Color fundus photograph · Remidio Fundus on Phone — 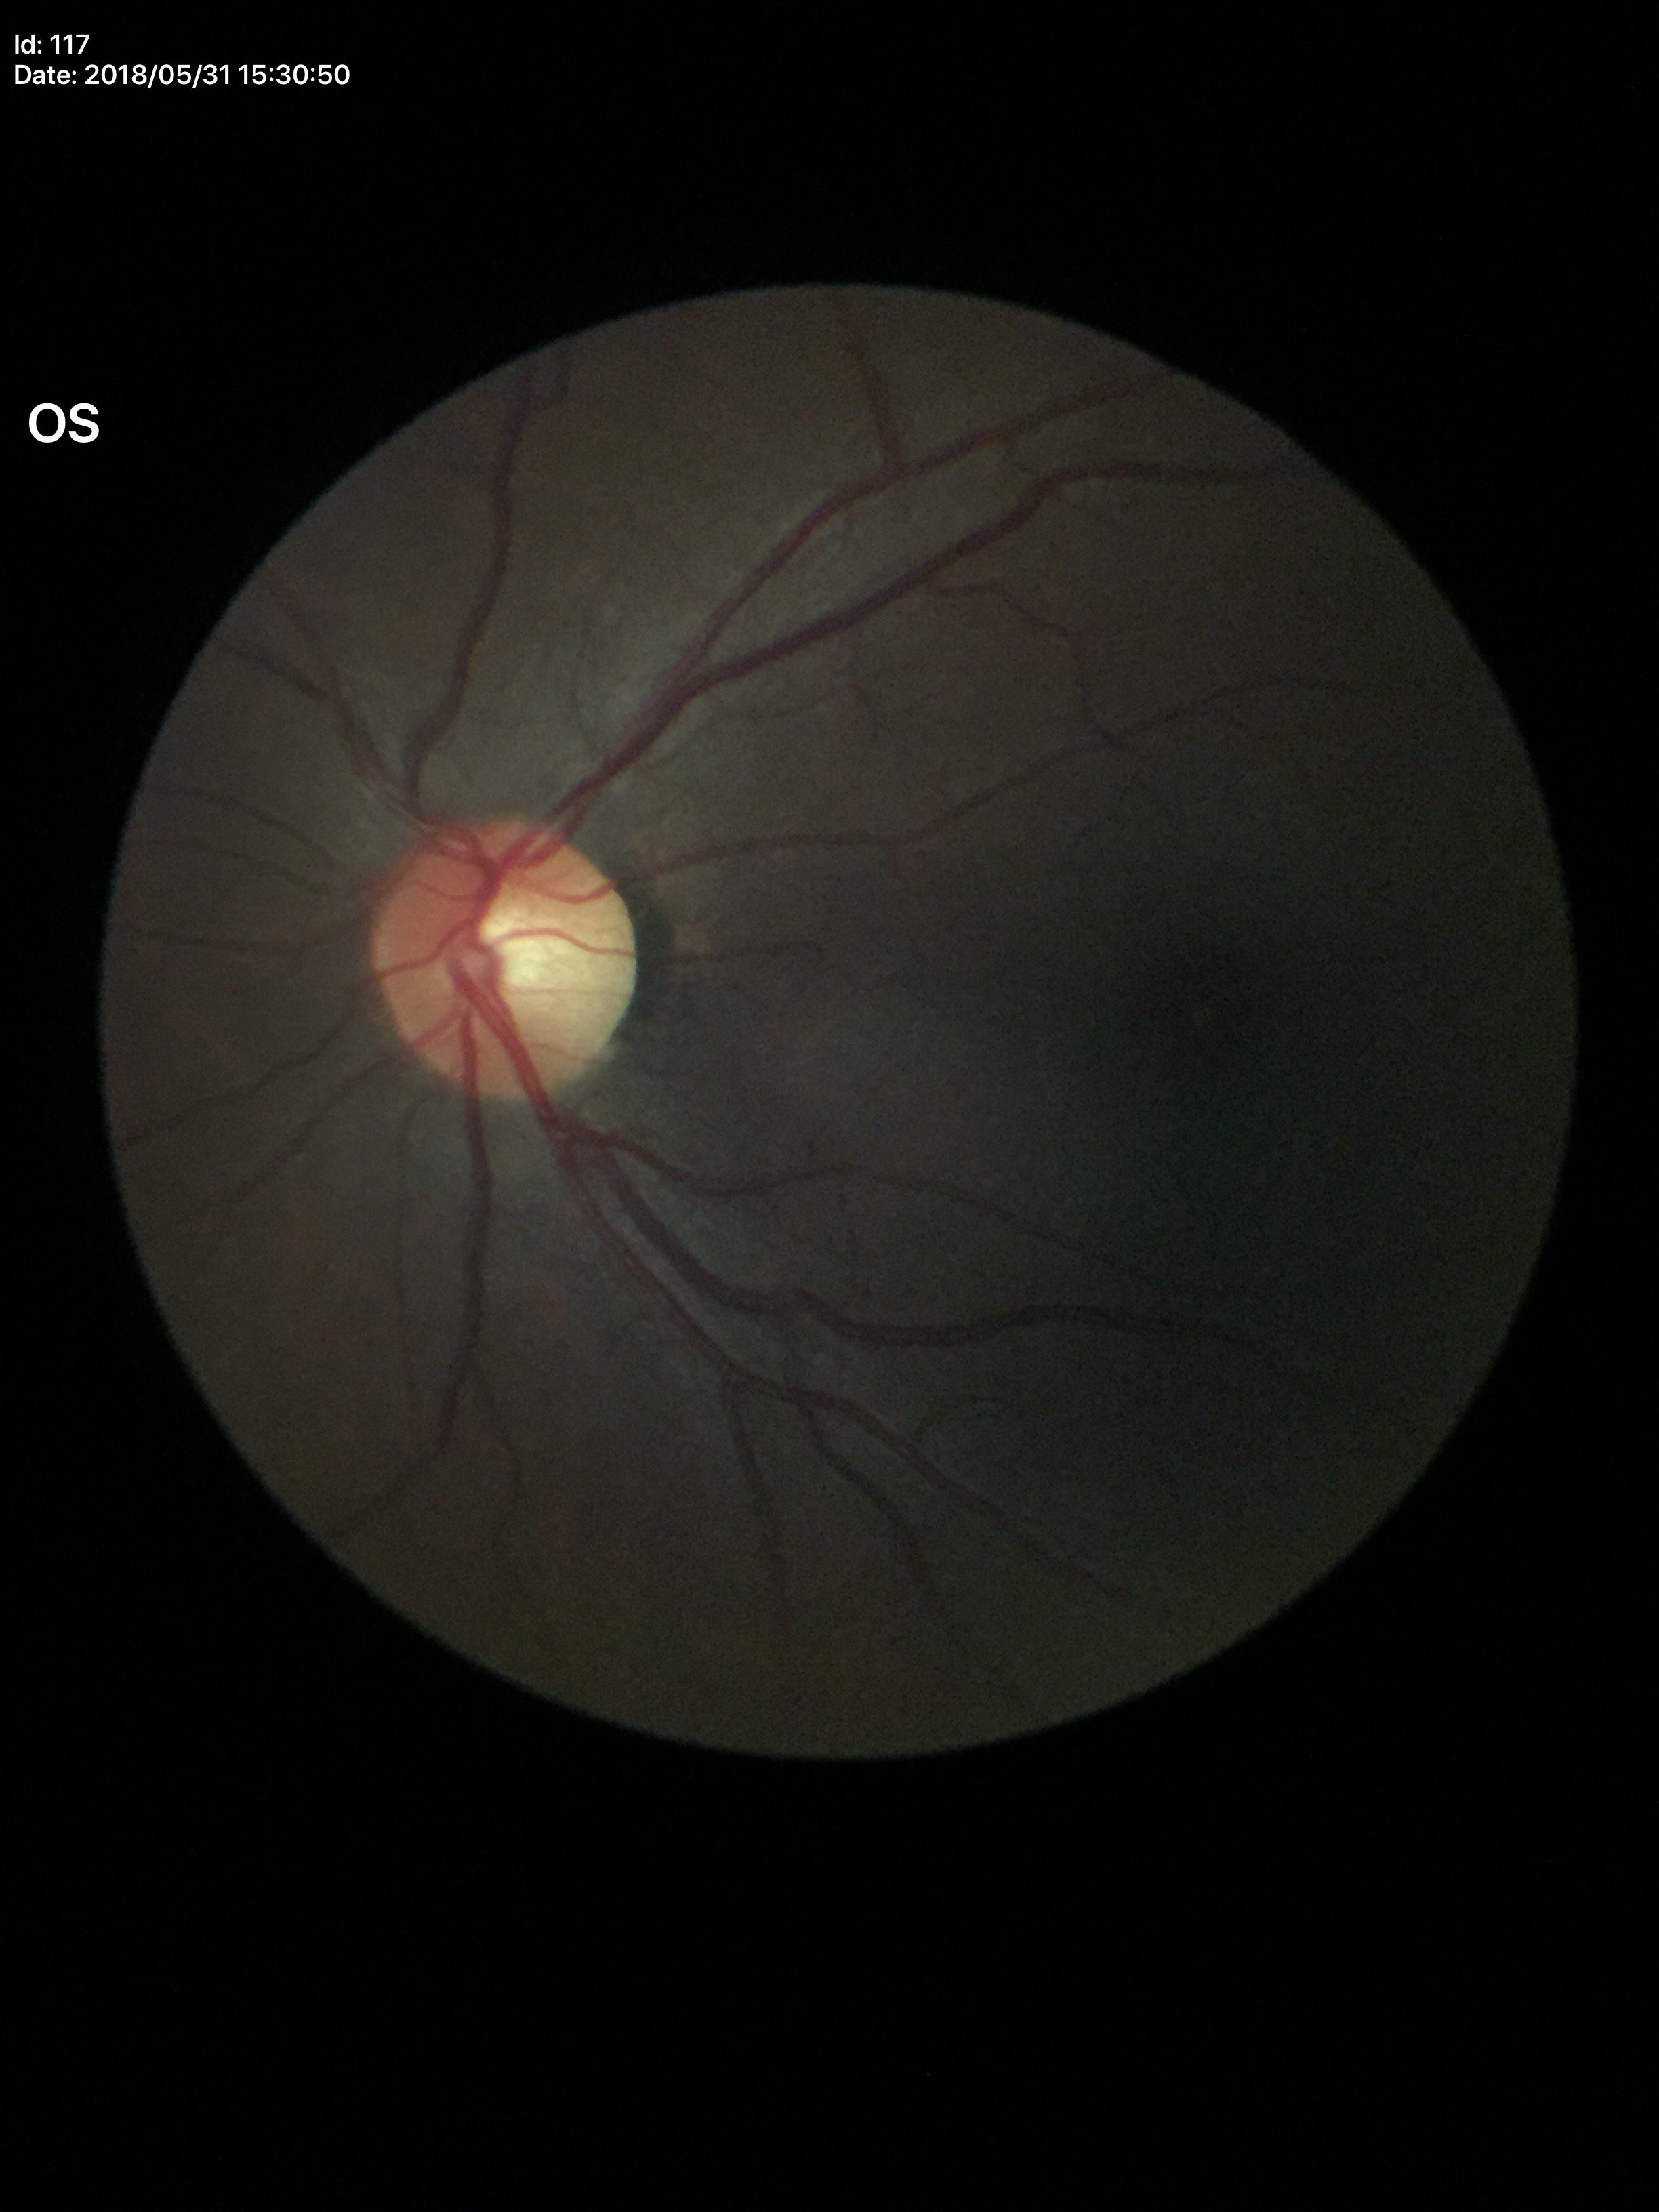
Findings:
– vertical cup-to-disc ratio: 0.49
– horizontal CDR: 0.48
– Glaucoma assessment: negative